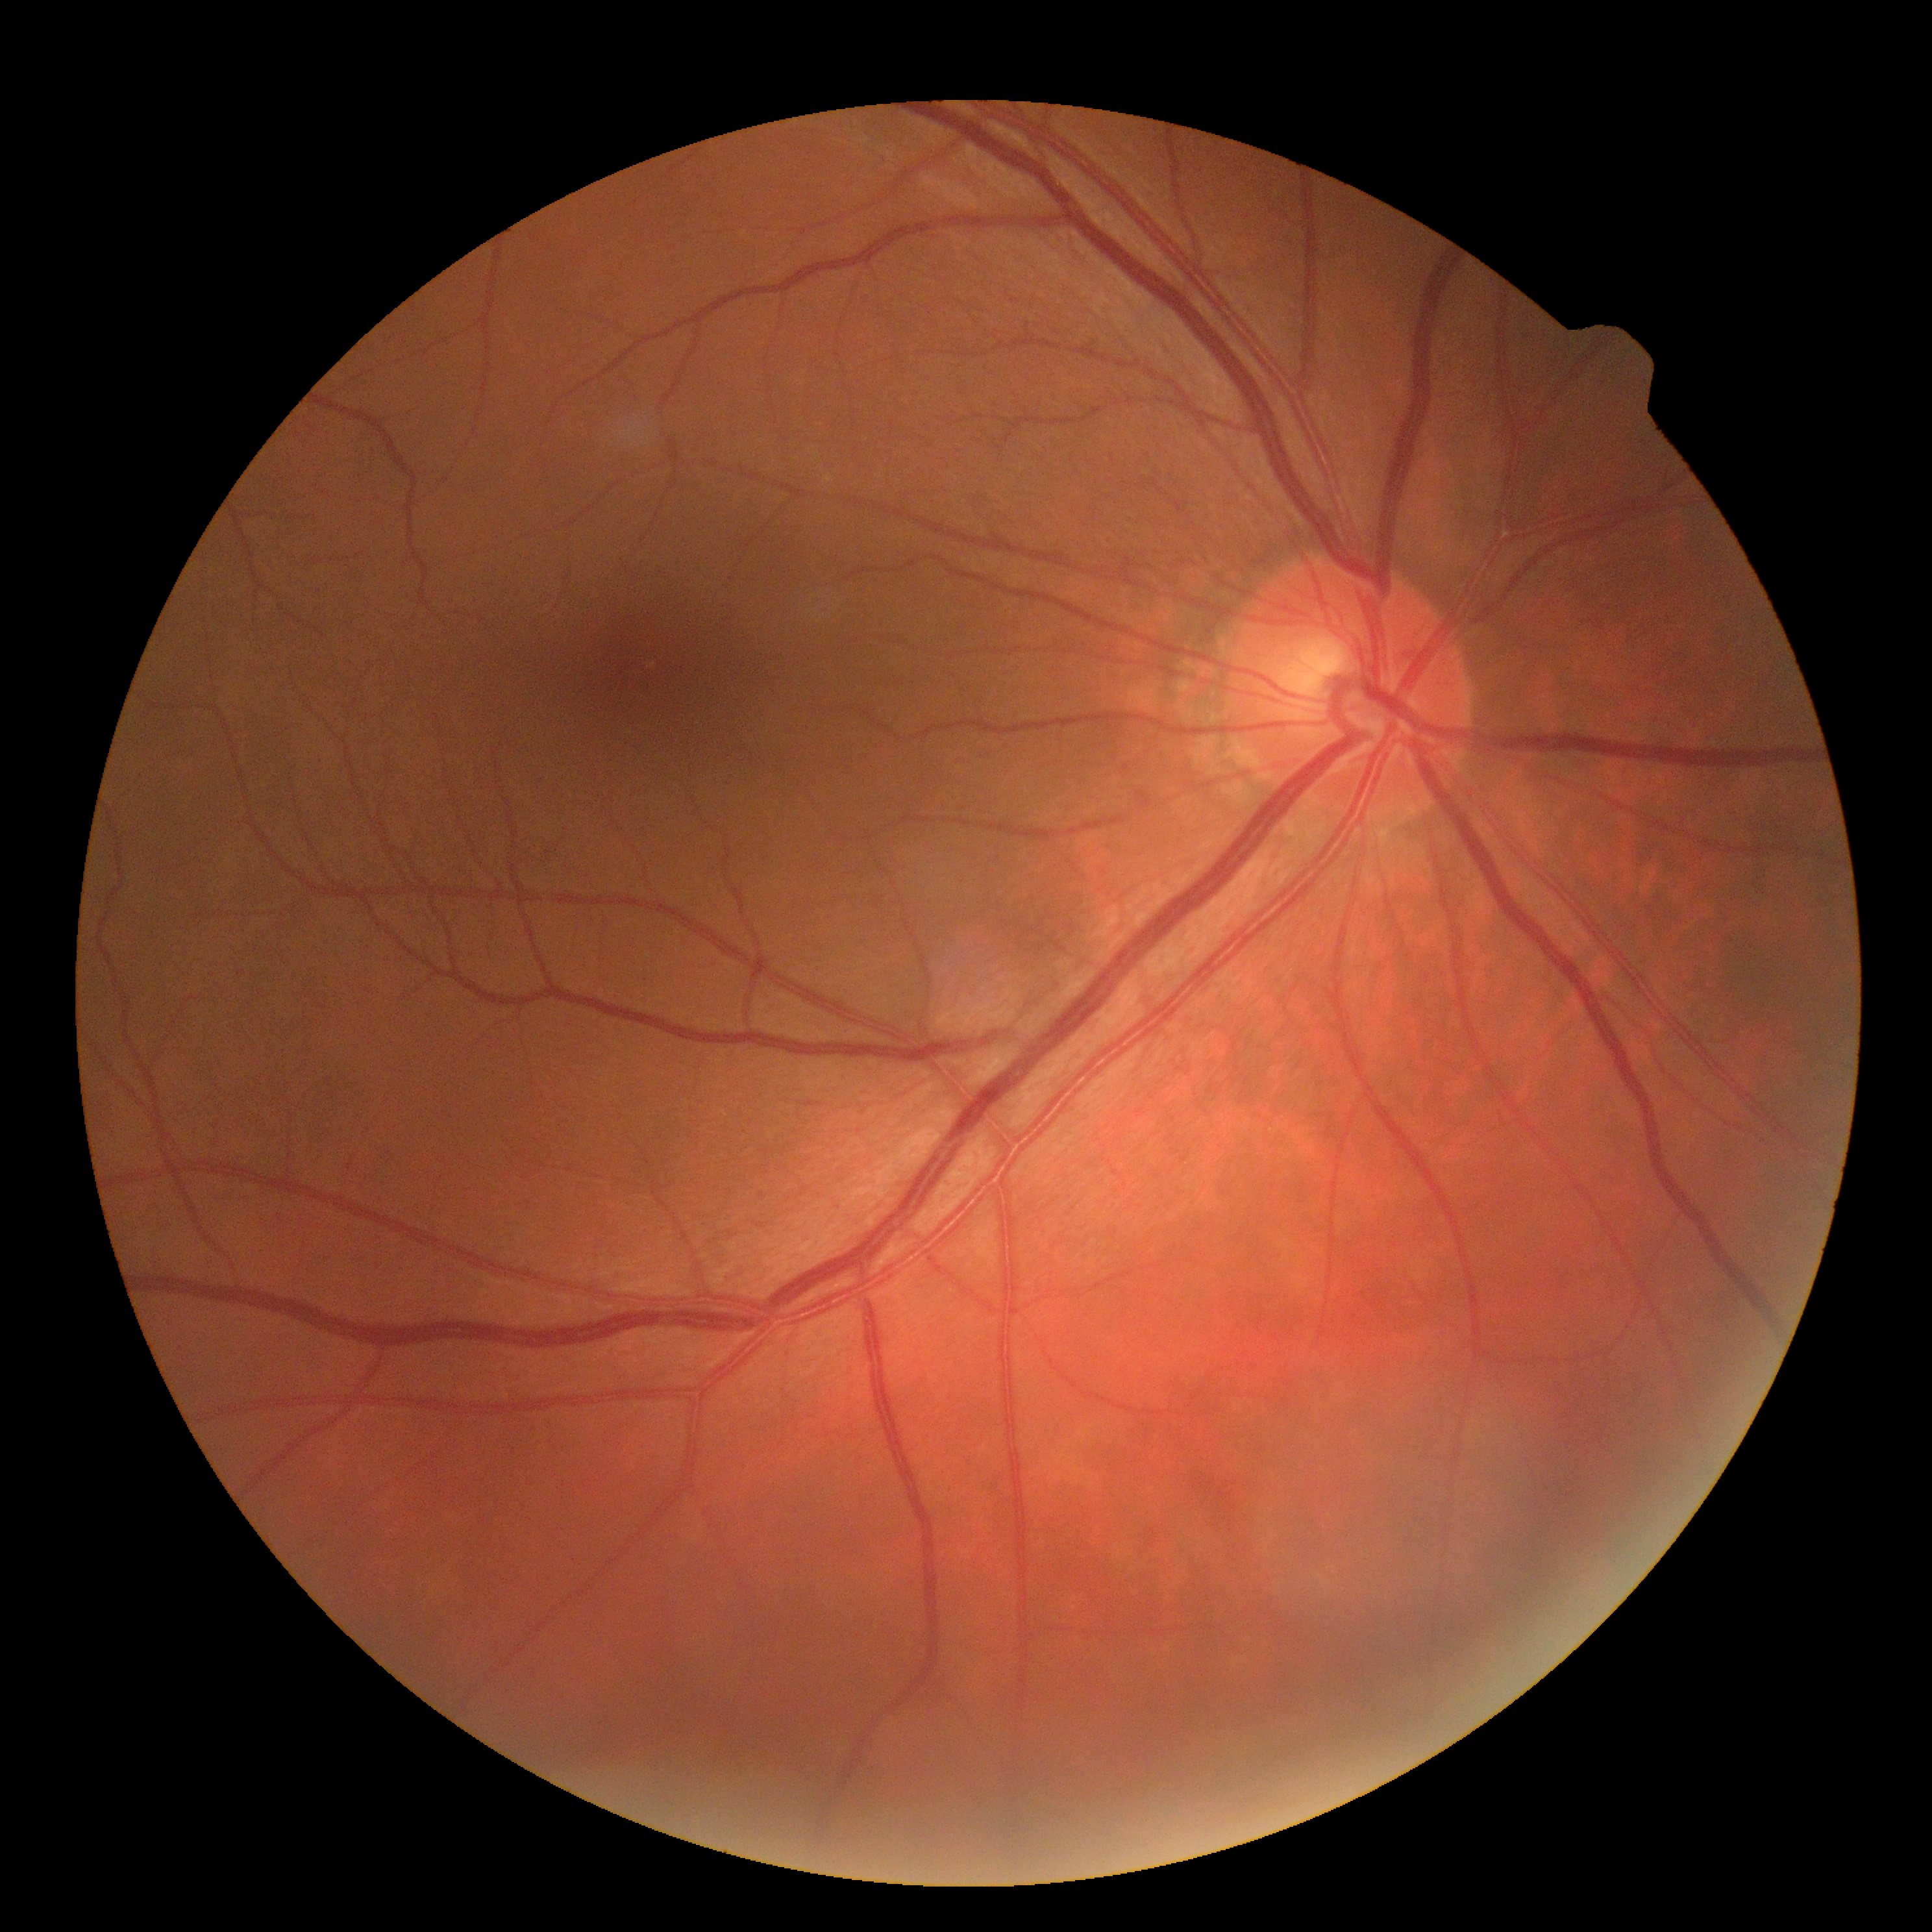
No diabetic retinal disease findings.
DR grade is no apparent diabetic retinopathy (0).